Pediatric wide-field fundus photograph
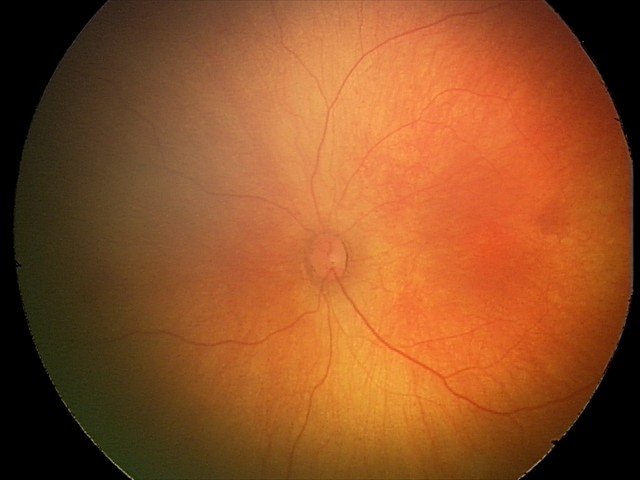 Screening examination diagnosed as physiological.